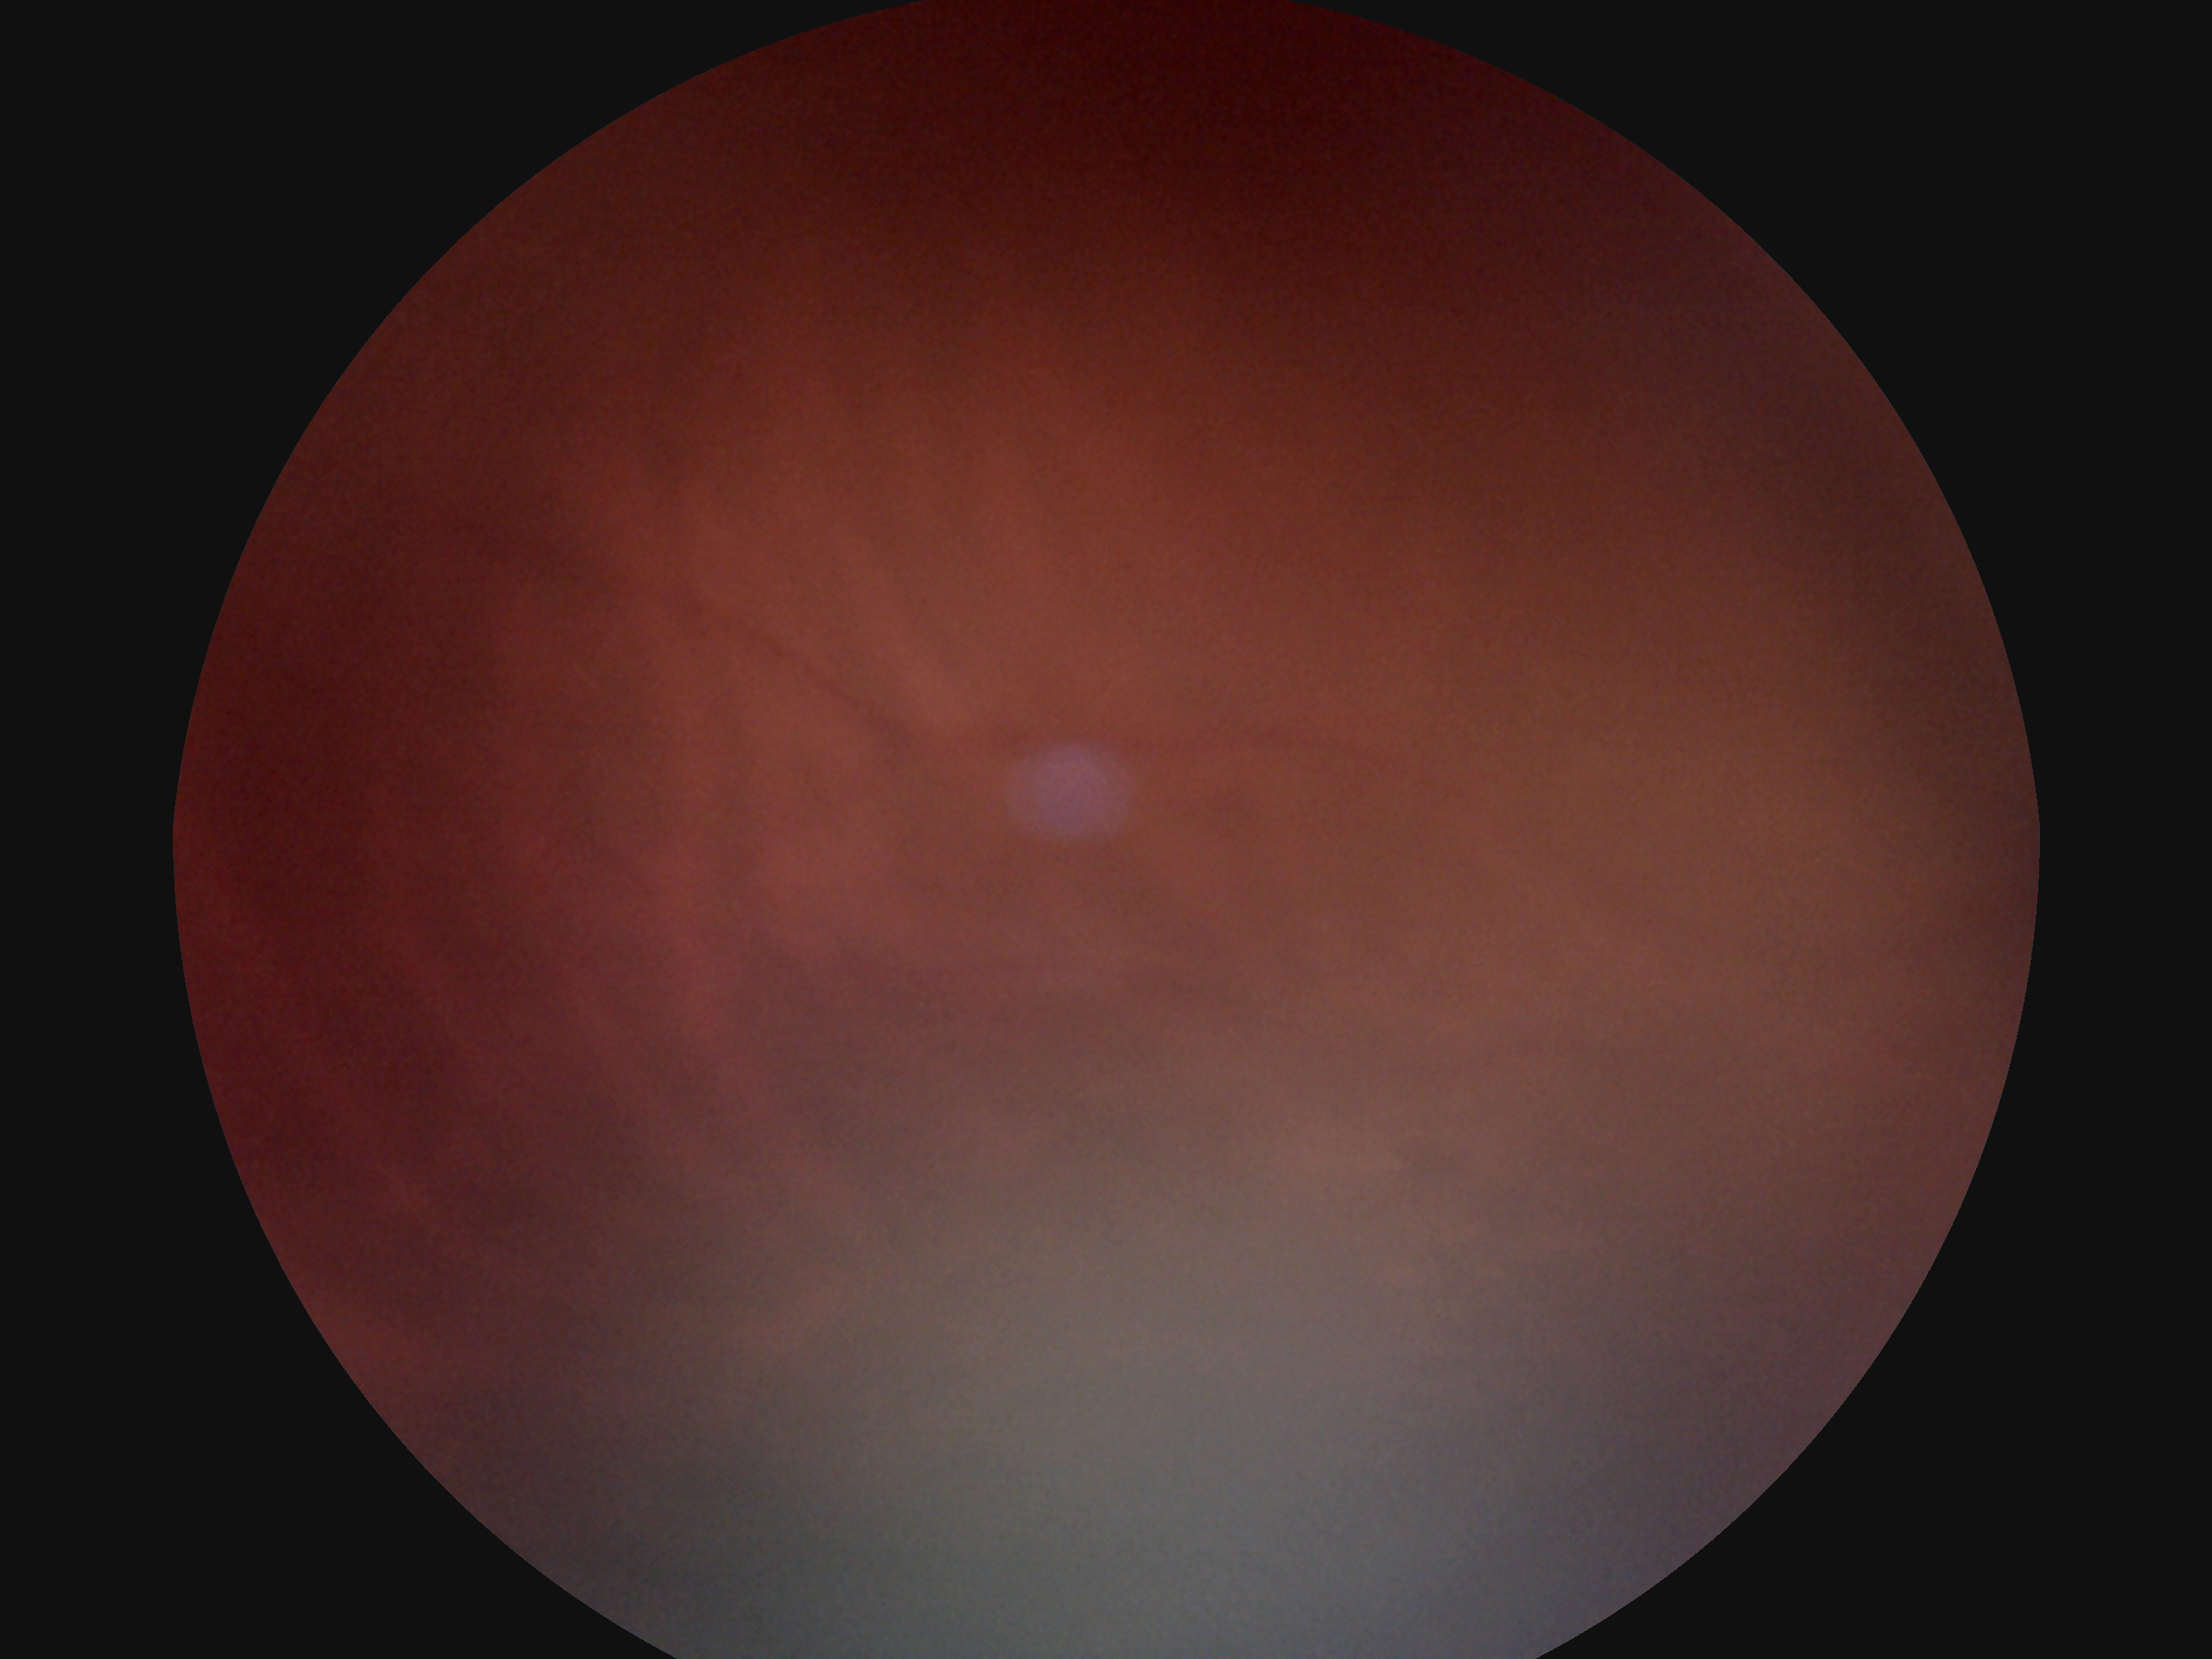 DR grade is ungradable due to poor image quality.